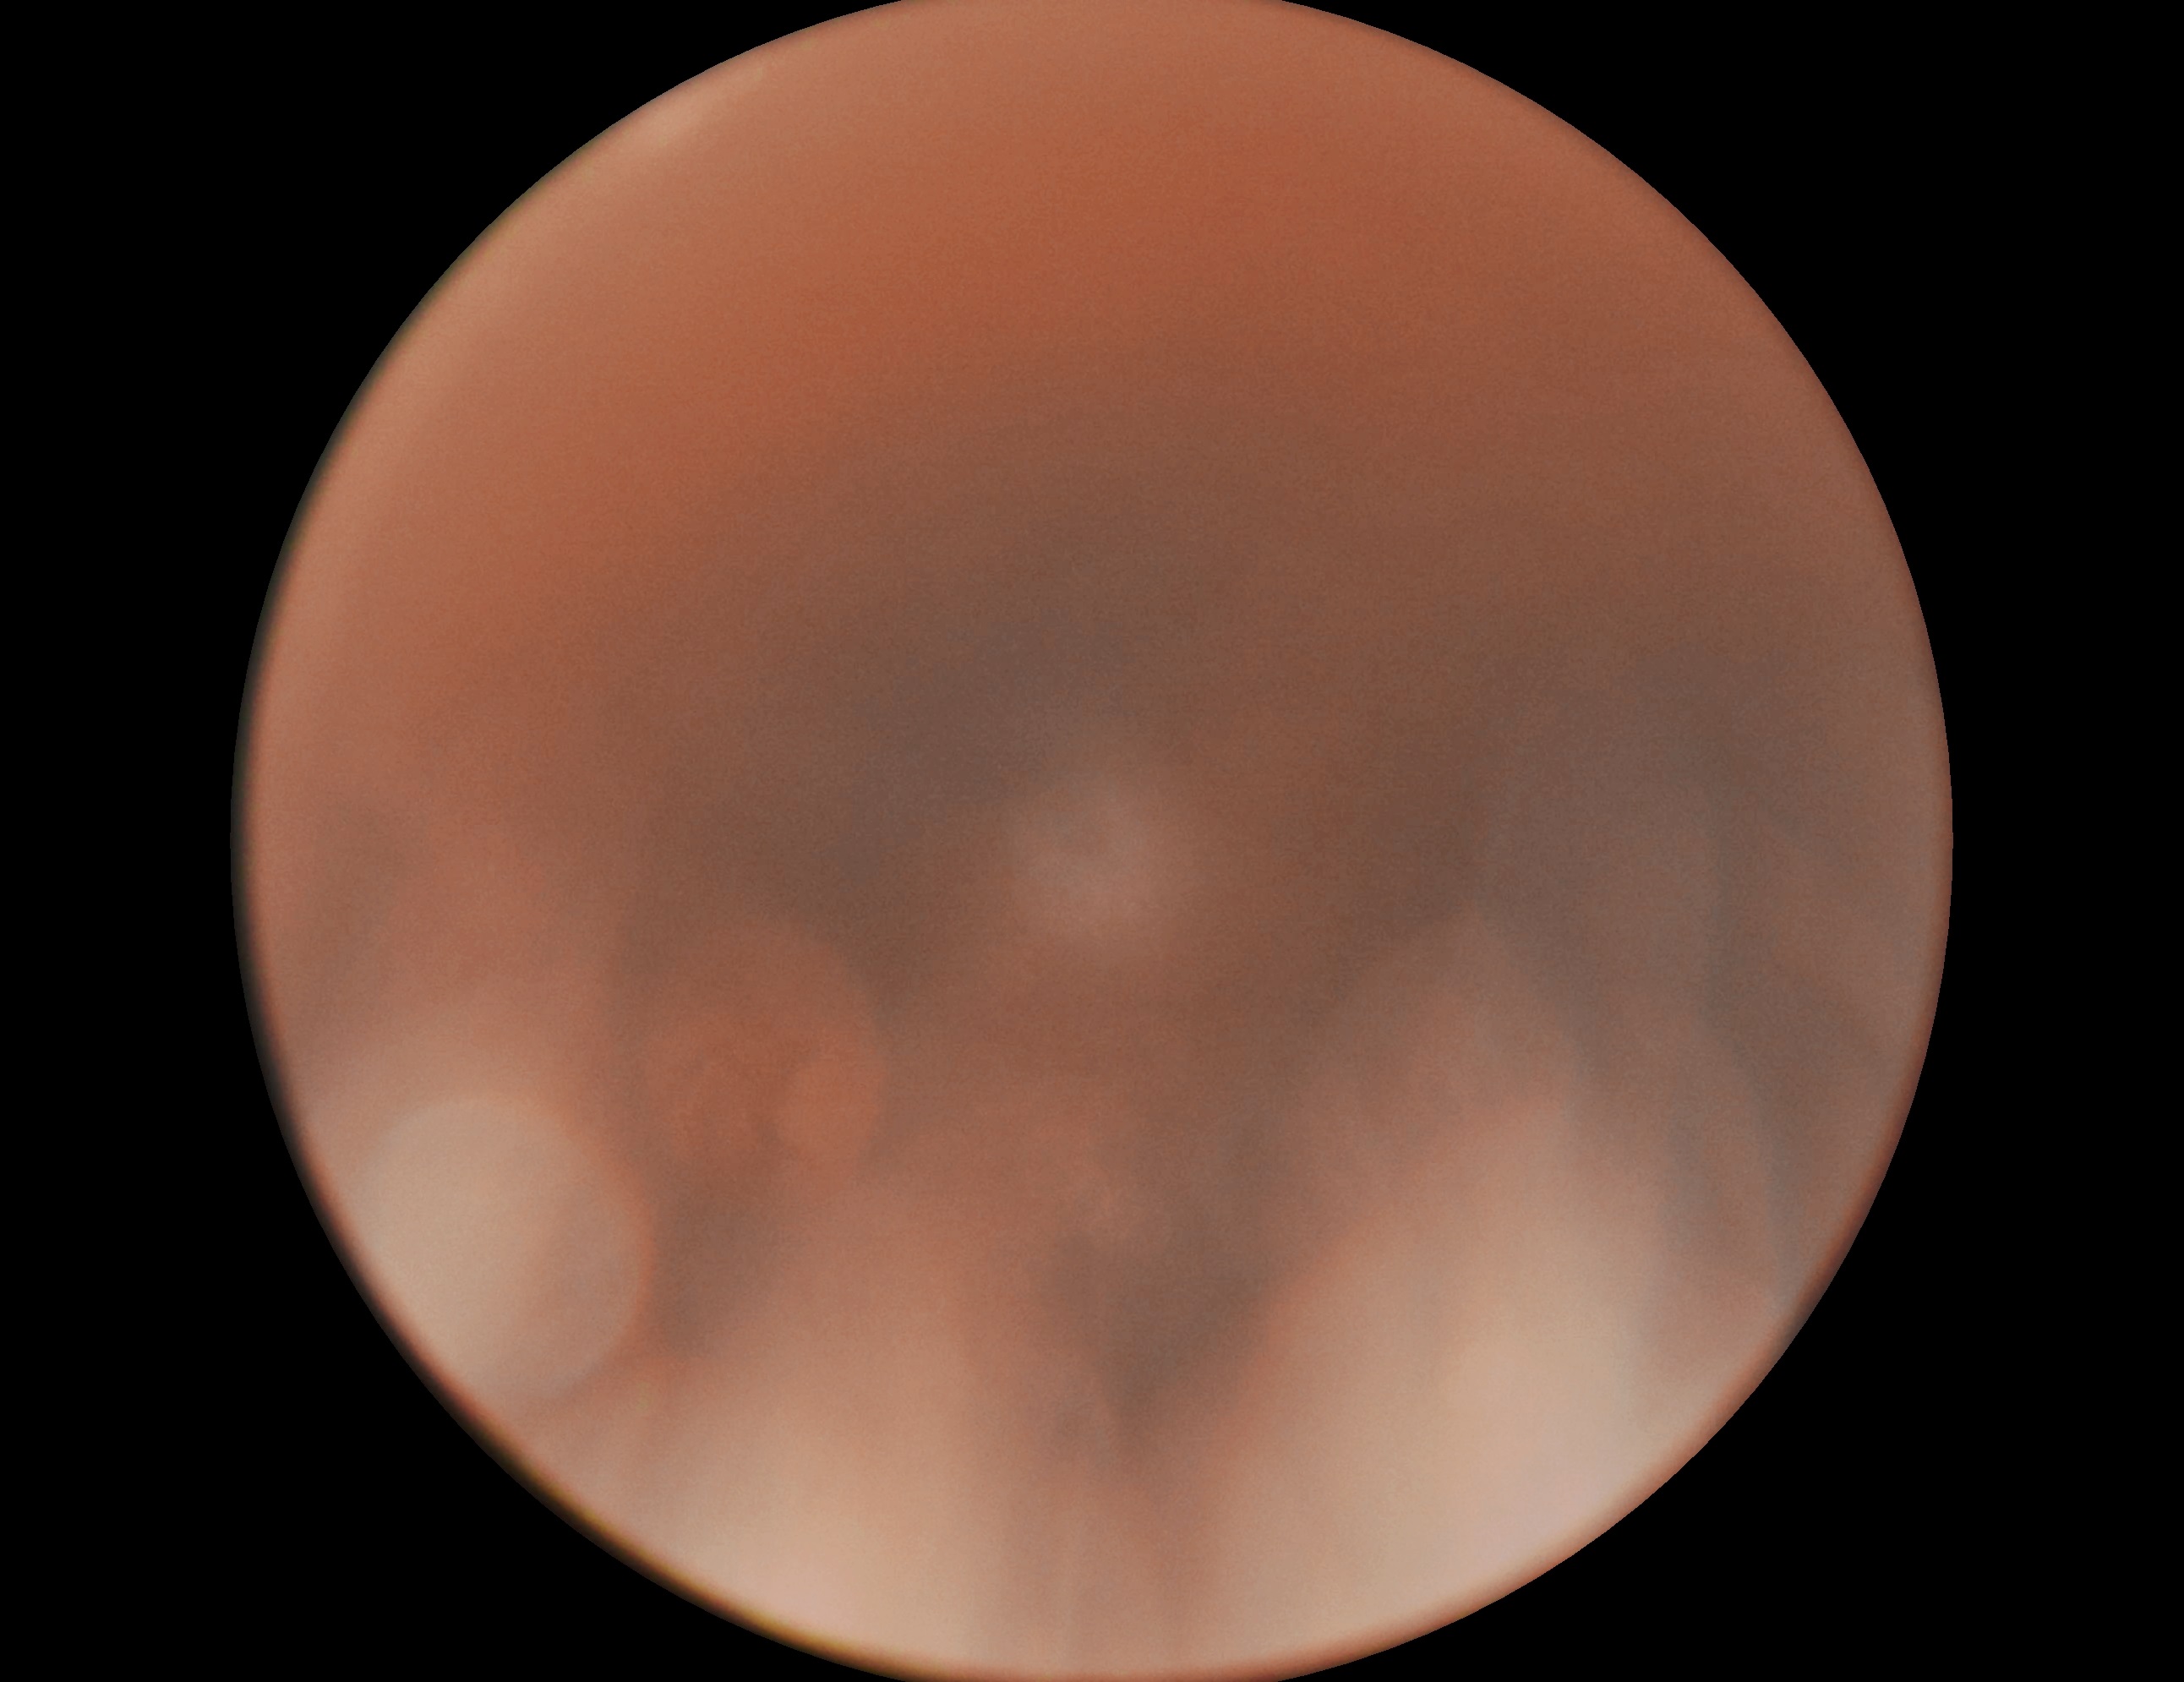
DR severity is ungradable due to poor image quality.
The image cannot be graded for diabetic retinopathy.